Wide-field contact fundus photograph of an infant; camera: Clarity RetCam 3 (130° FOV).
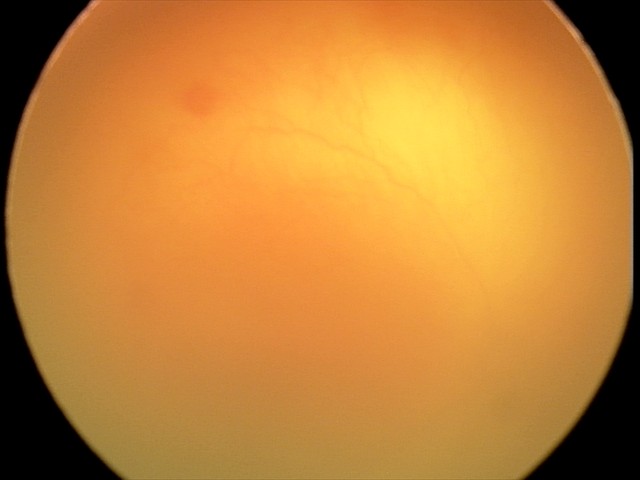
From an examination with diagnosis of aggressive retinopathy of prematurity (A-ROP). Plus disease present.